45° field of view
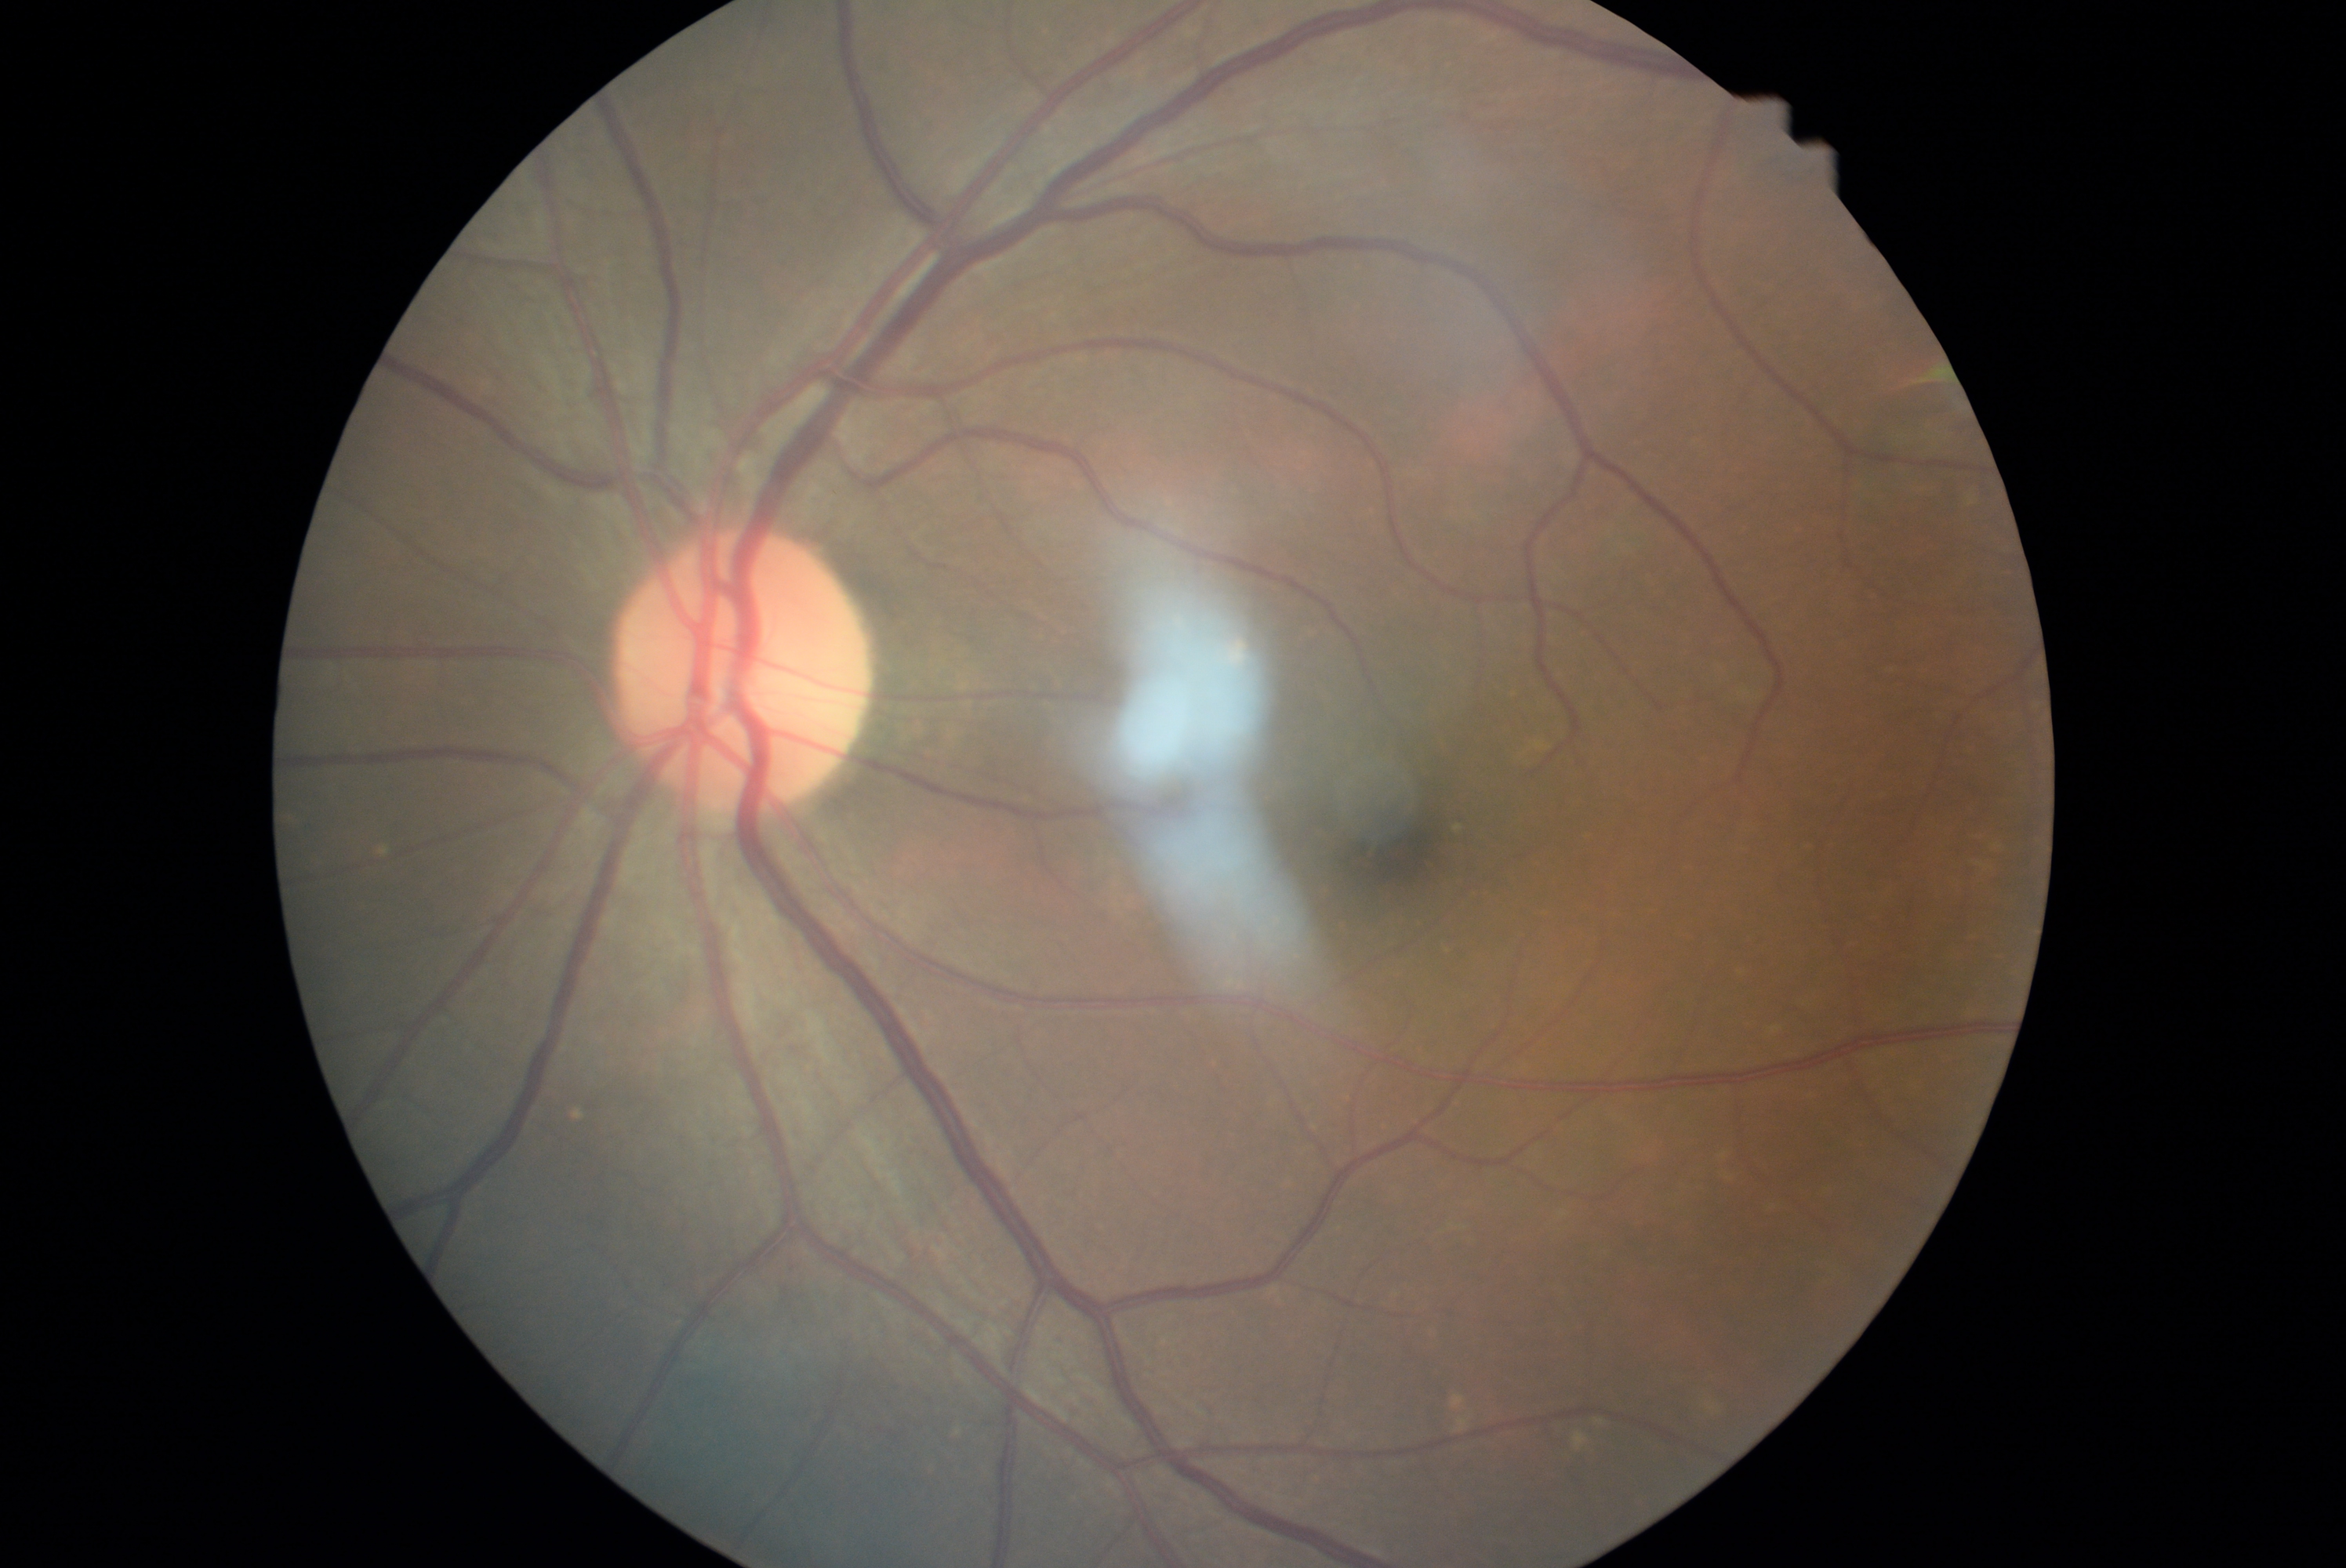 No apparent diabetic retinopathy.
Diabetic retinopathy (DR): grade 0 (no apparent retinopathy).